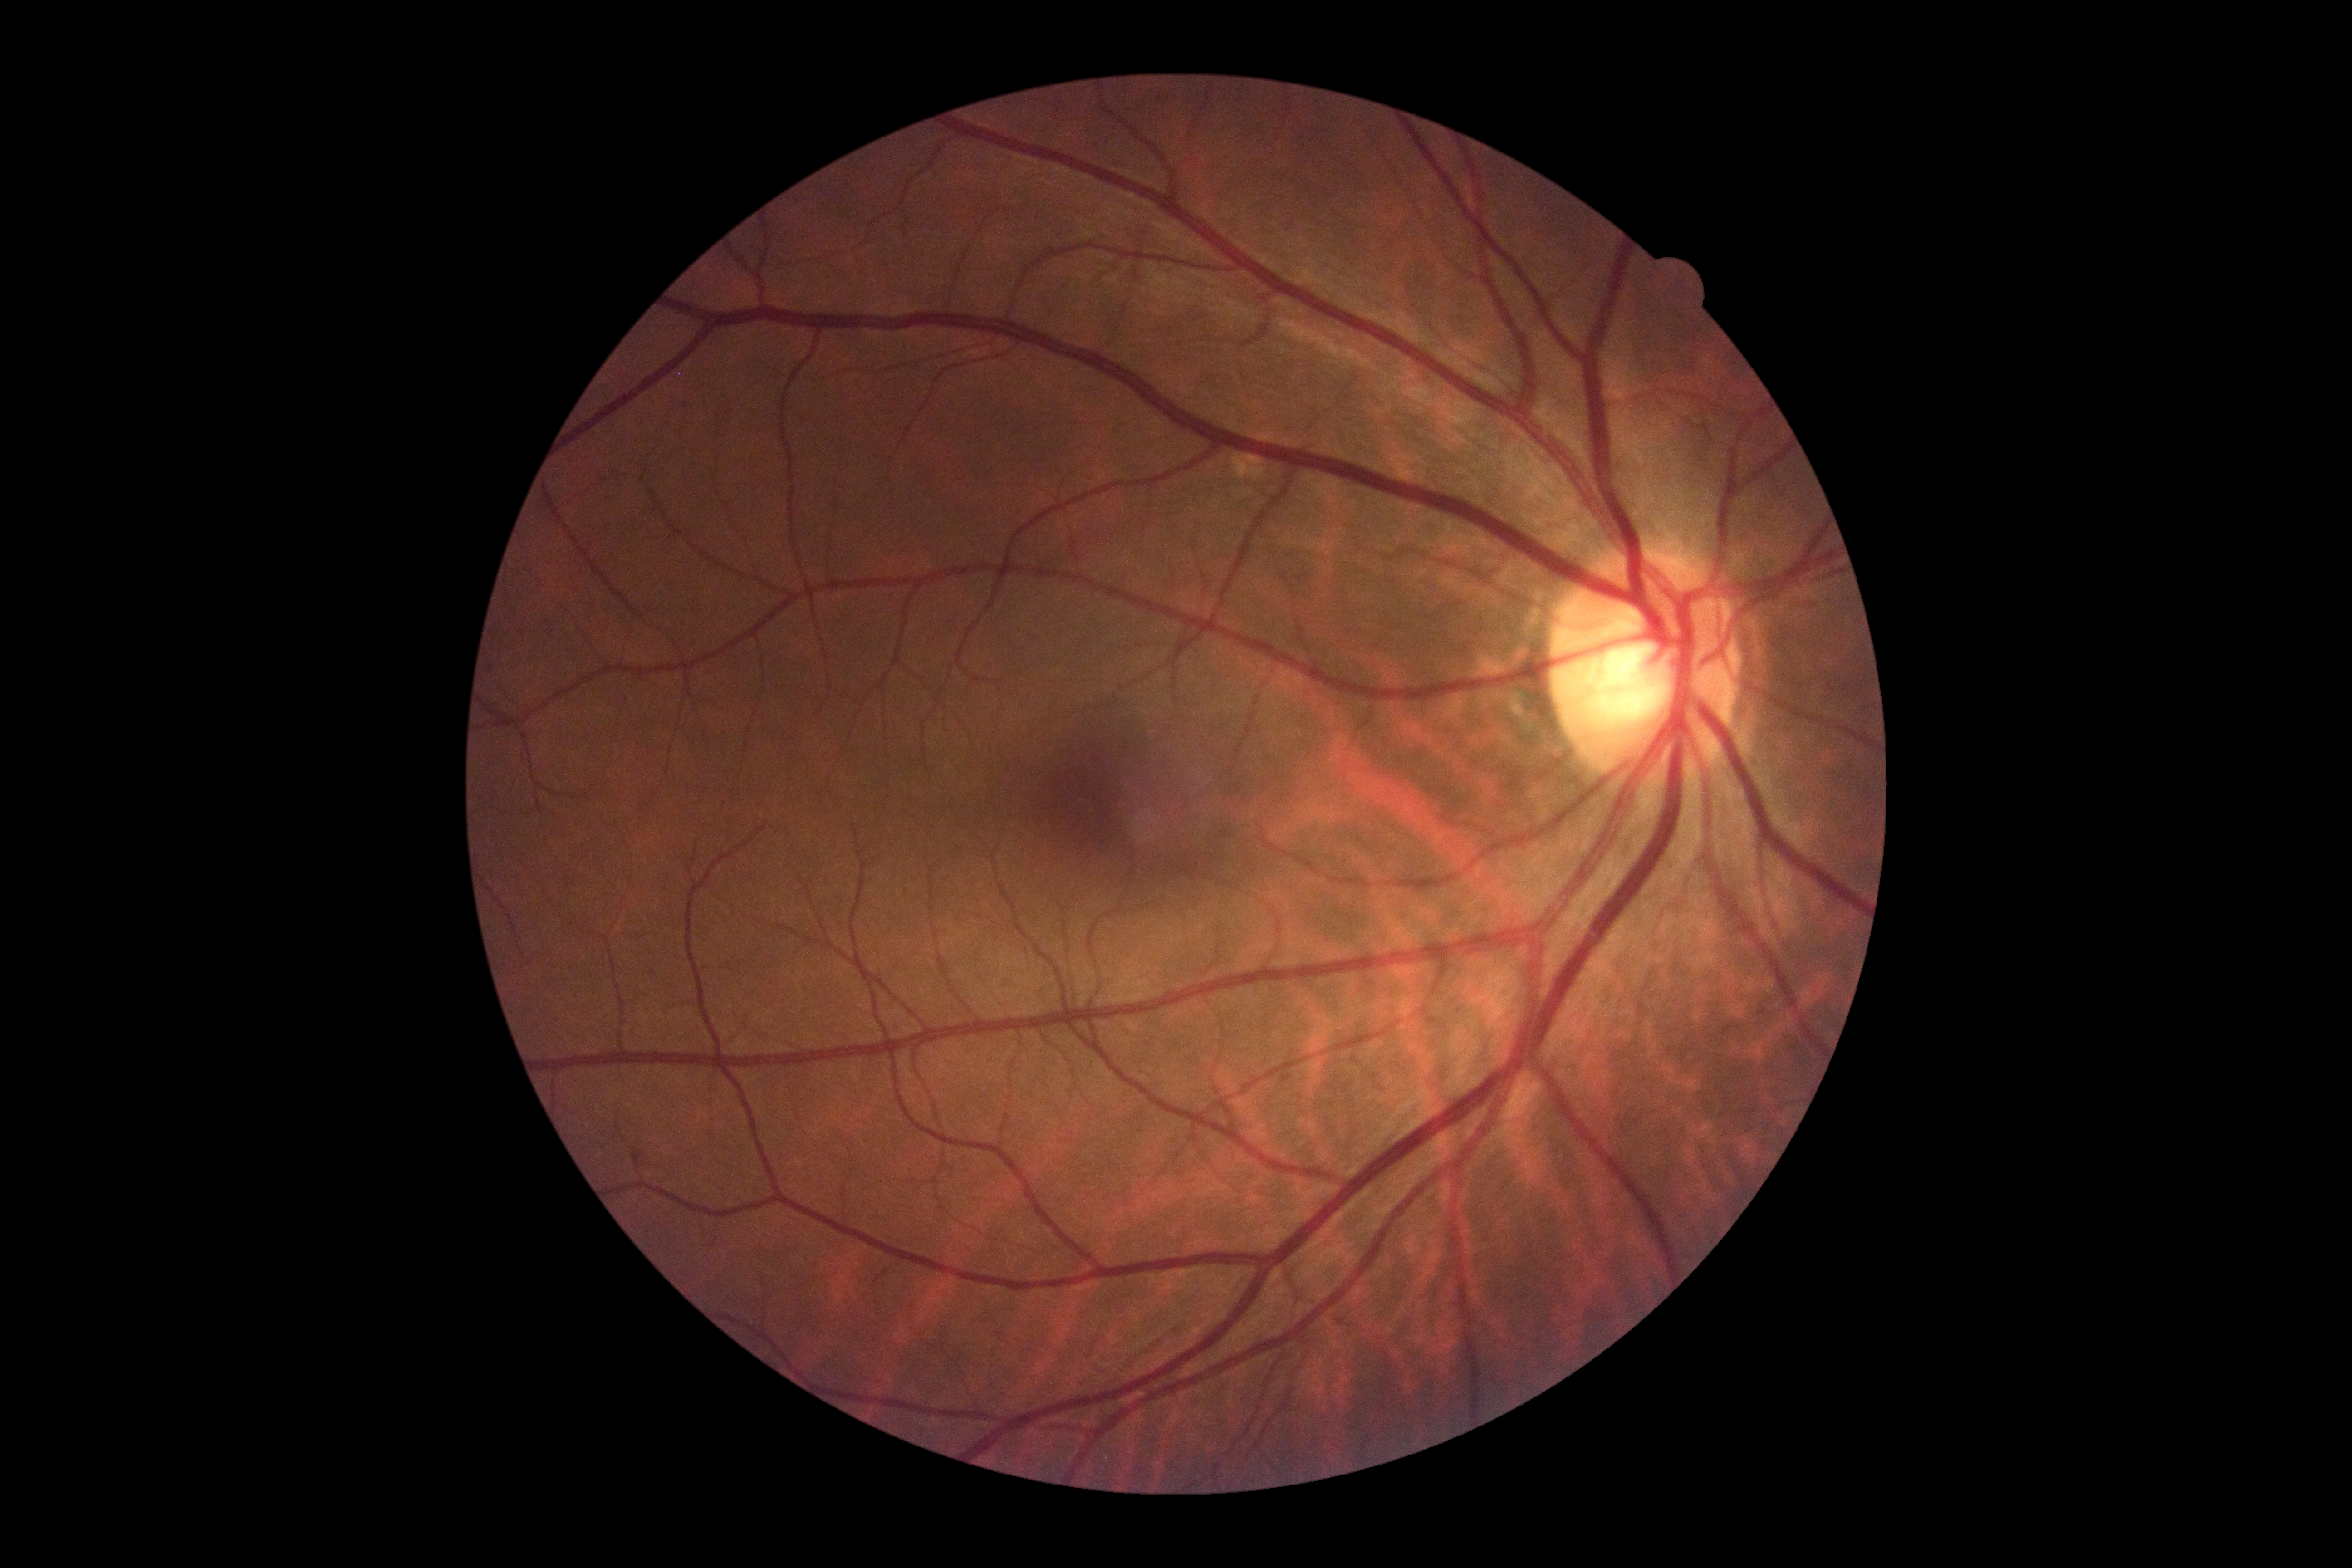
Diabetic retinopathy: no apparent retinopathy (grade 0).